Davis DR grading; 45 degree fundus photograph; fundus photo.
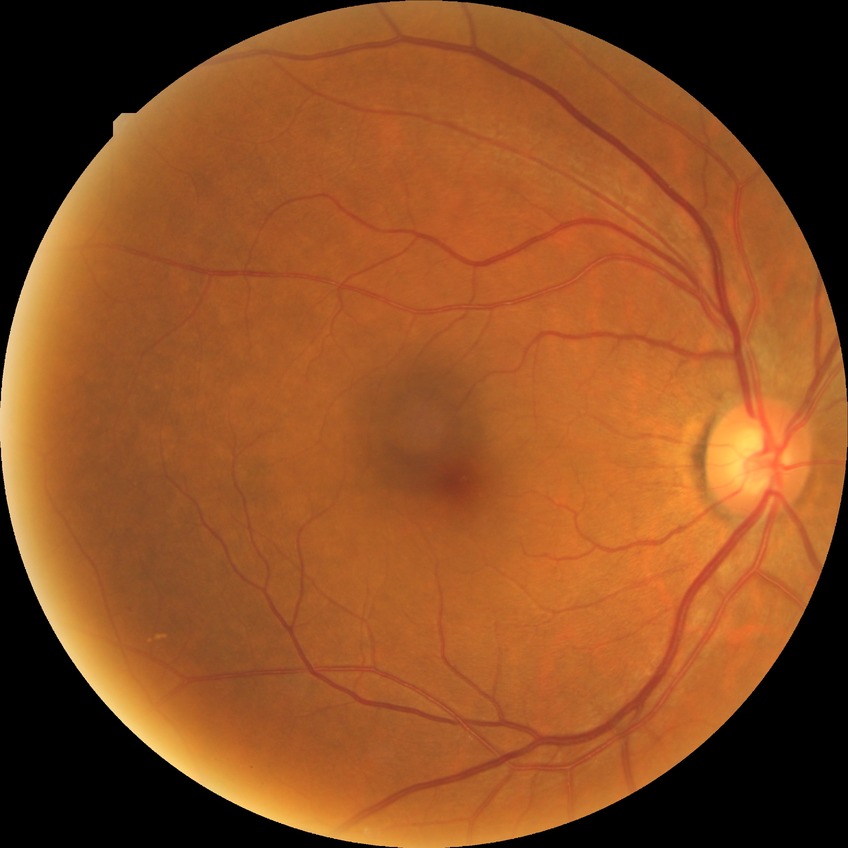
Diabetic retinopathy (DR): simple diabetic retinopathy (SDR).